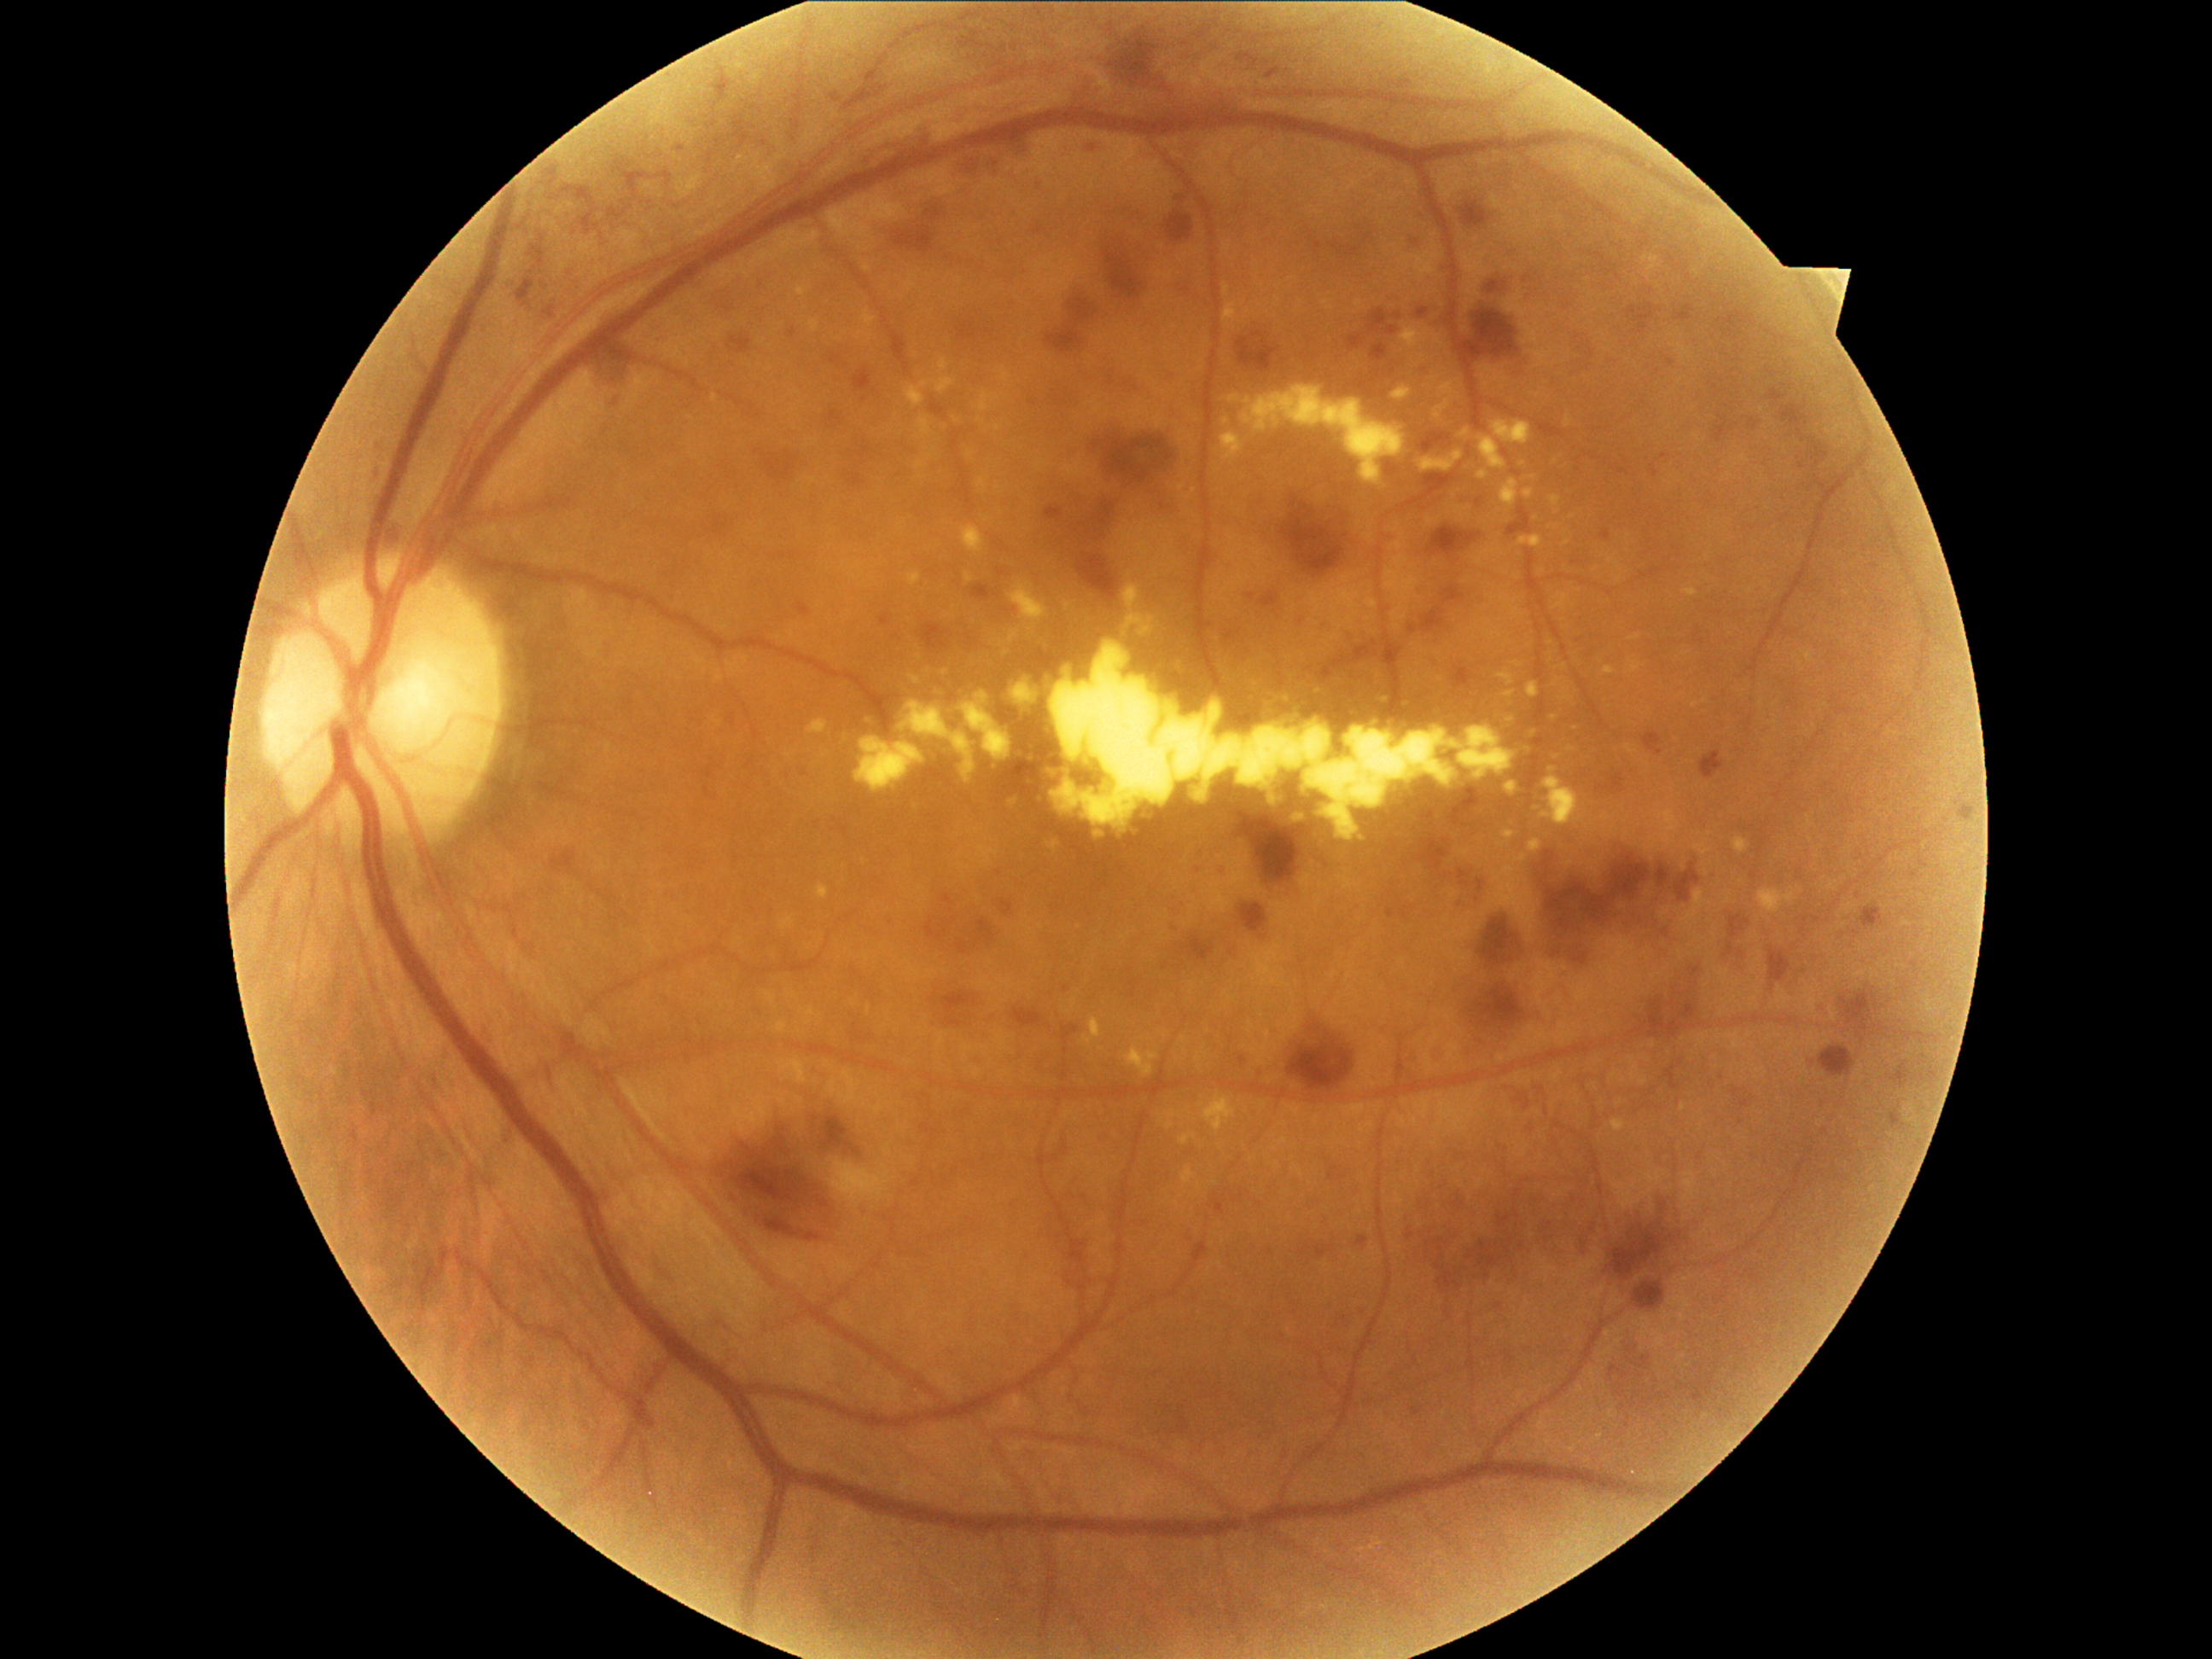 {"partial": true, "dr_grade": 3, "lesions": {"ex": [[1523, 489, 1534, 501], [1503, 672, 1522, 684], [1479, 472, 1486, 482], [1016, 595, 1047, 617], [1126, 585, 1143, 607], [1643, 257, 1660, 272], [1491, 421, 1532, 446], [1061, 665, 1071, 680], [1083, 1016, 1102, 1044], [1527, 682, 1539, 699], [1204, 1097, 1237, 1134], [897, 690, 1020, 786]], "ex_small_approx": [[1523, 465], [1403, 704]], "he": [[1445, 581, 1462, 605], [1412, 827, 1452, 871], [1001, 127, 1035, 156], [1457, 897, 1469, 912], [849, 446, 873, 460], [1045, 294, 1100, 356], [1424, 1231, 1470, 1295], [957, 919, 996, 955], [1747, 417, 1762, 433], [1406, 1228, 1416, 1240], [1233, 332, 1243, 361], [1180, 936, 1214, 962], [706, 515, 730, 538], [791, 329, 798, 339], [926, 916, 958, 941], [1062, 494, 1129, 603]], "he_small_approx": [[997, 984], [1805, 467]]}}